Image size 640x480. Pediatric wide-field fundus photograph: 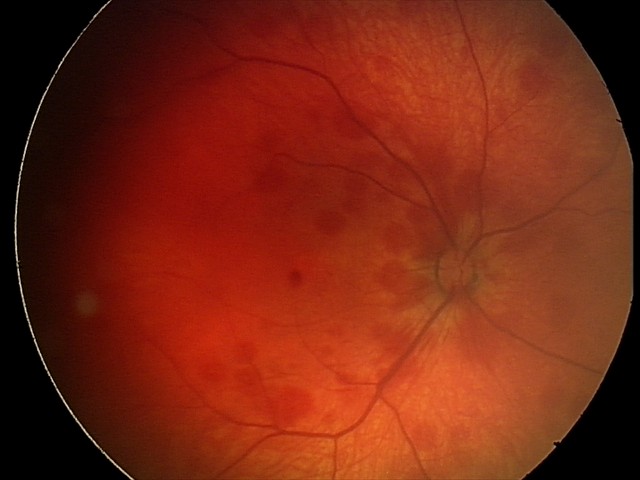

Screening examination consistent with retinal hemorrhages.